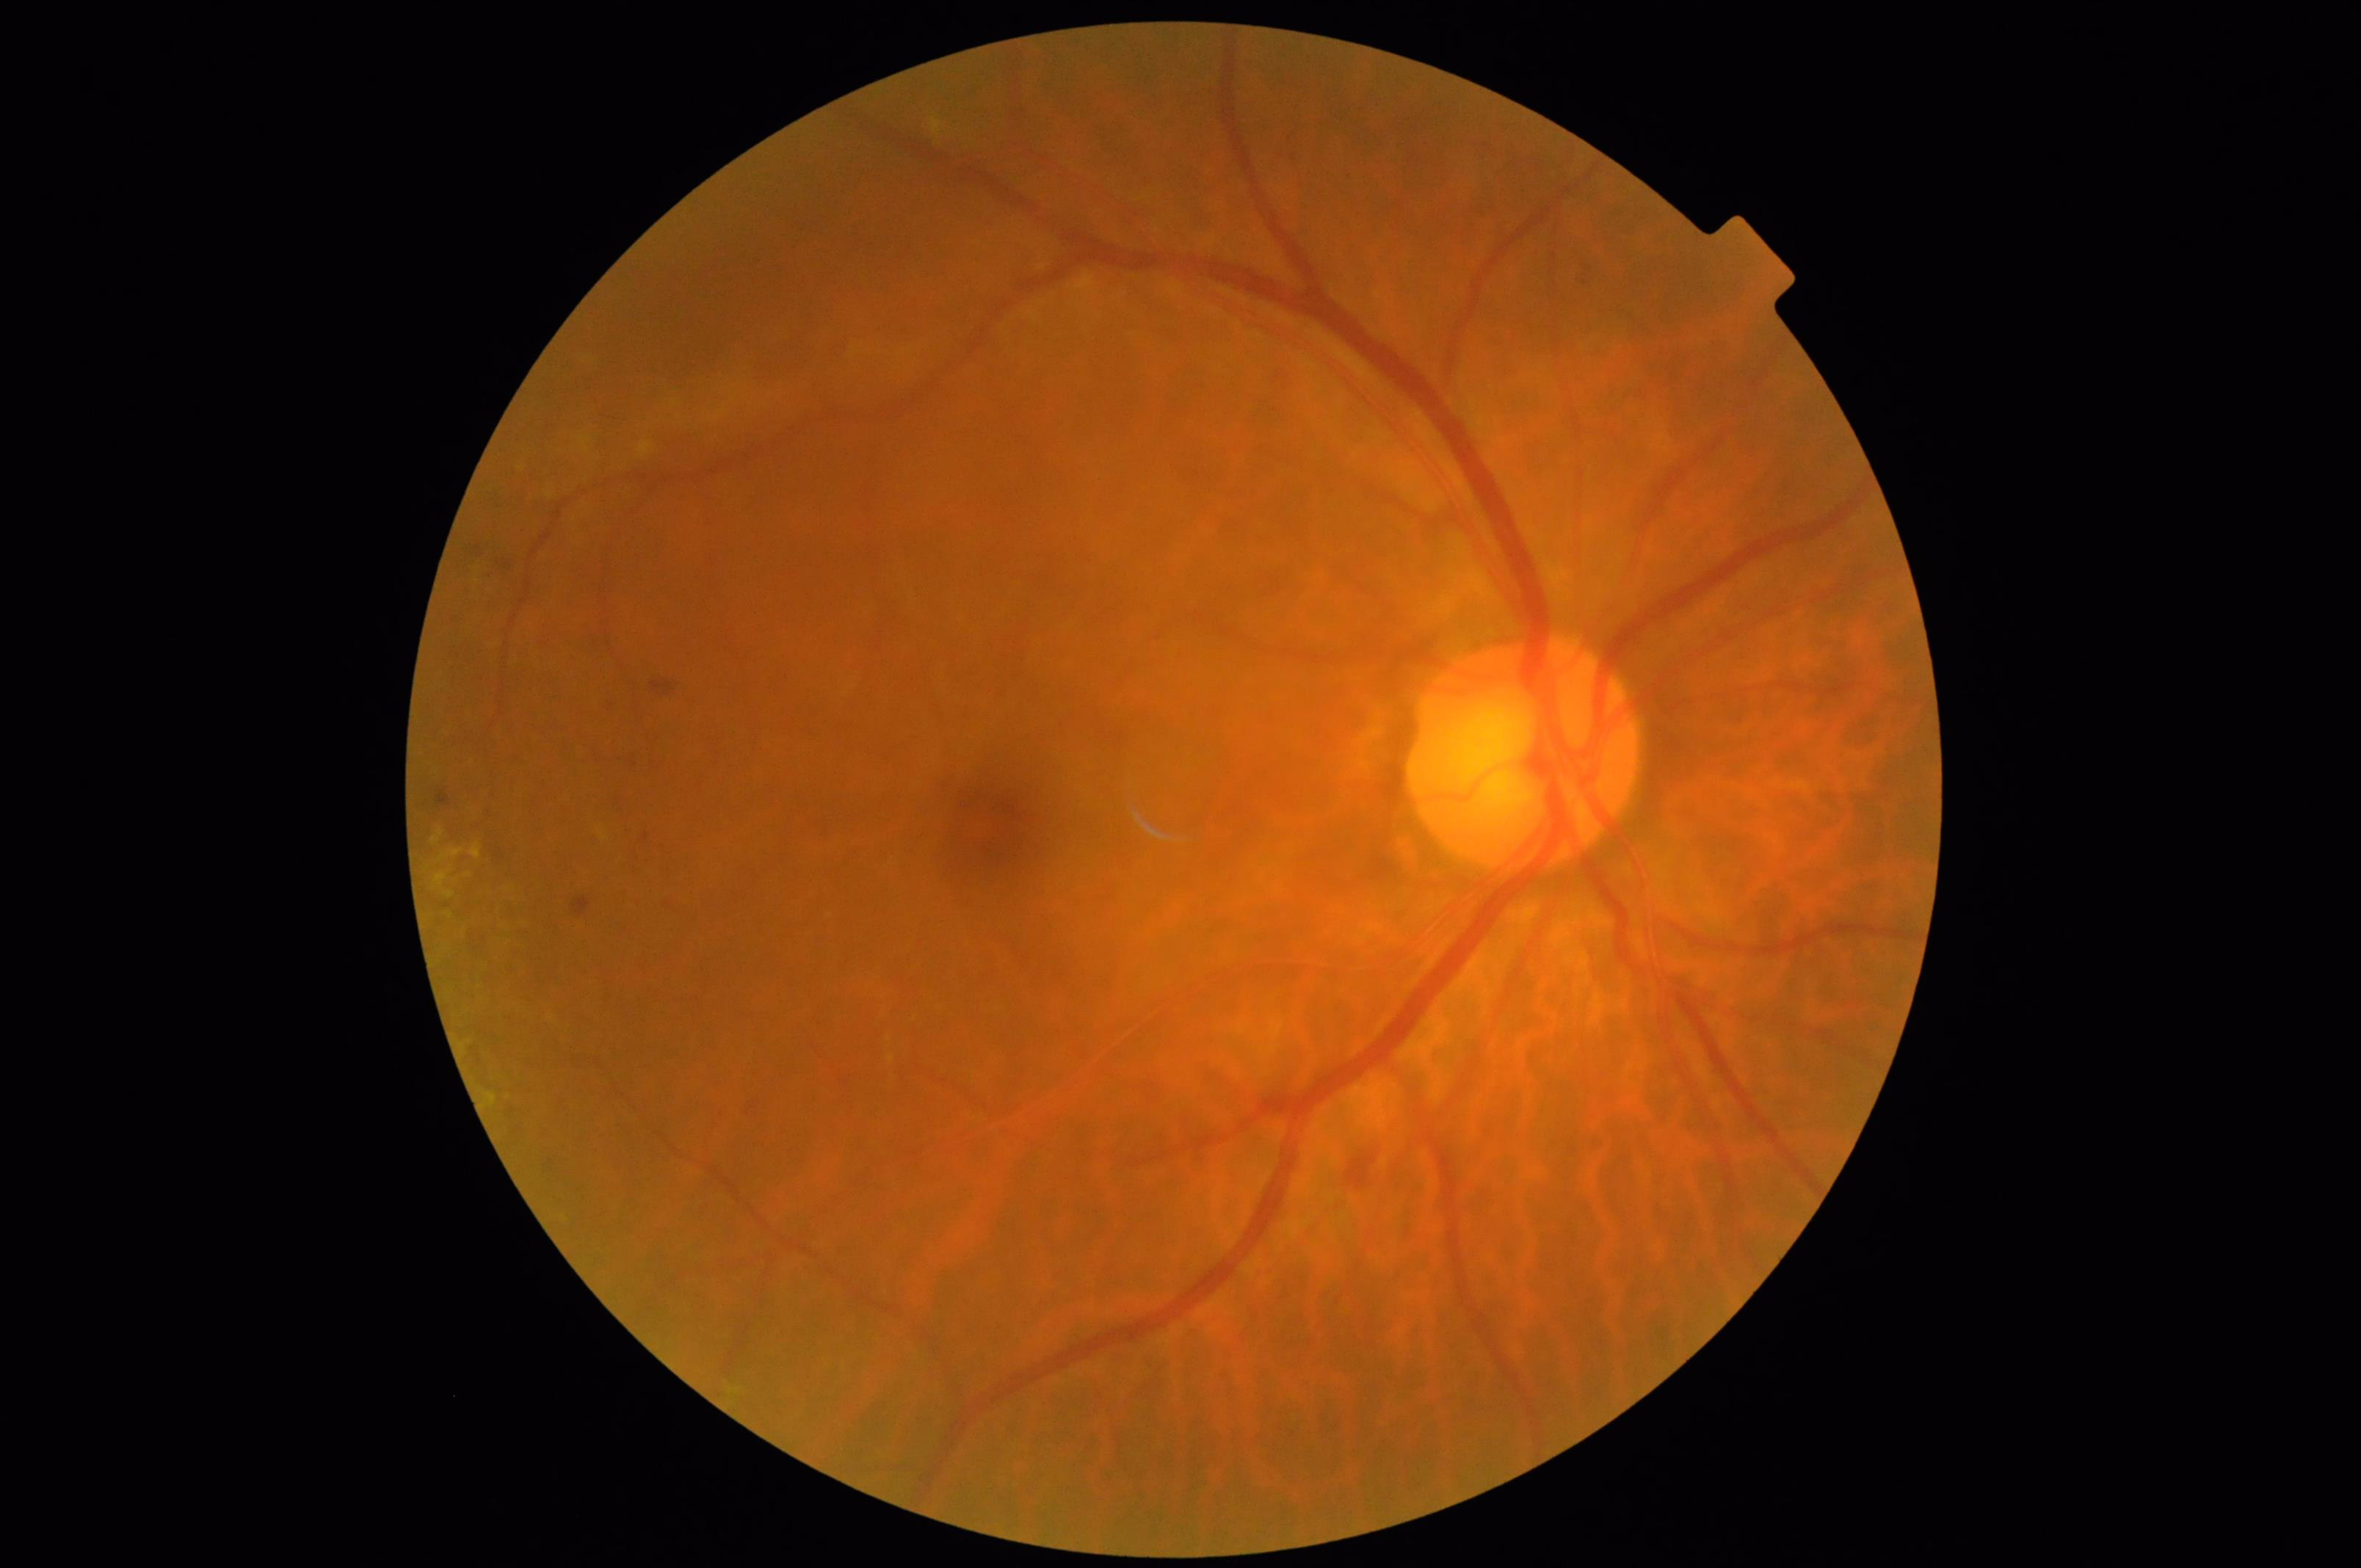 Overall quality: satisfactory | Contrast: satisfactory | Focus: blurry.